1240x1240px · infant wide-field fundus photograph · Phoenix ICON, 100° FOV.
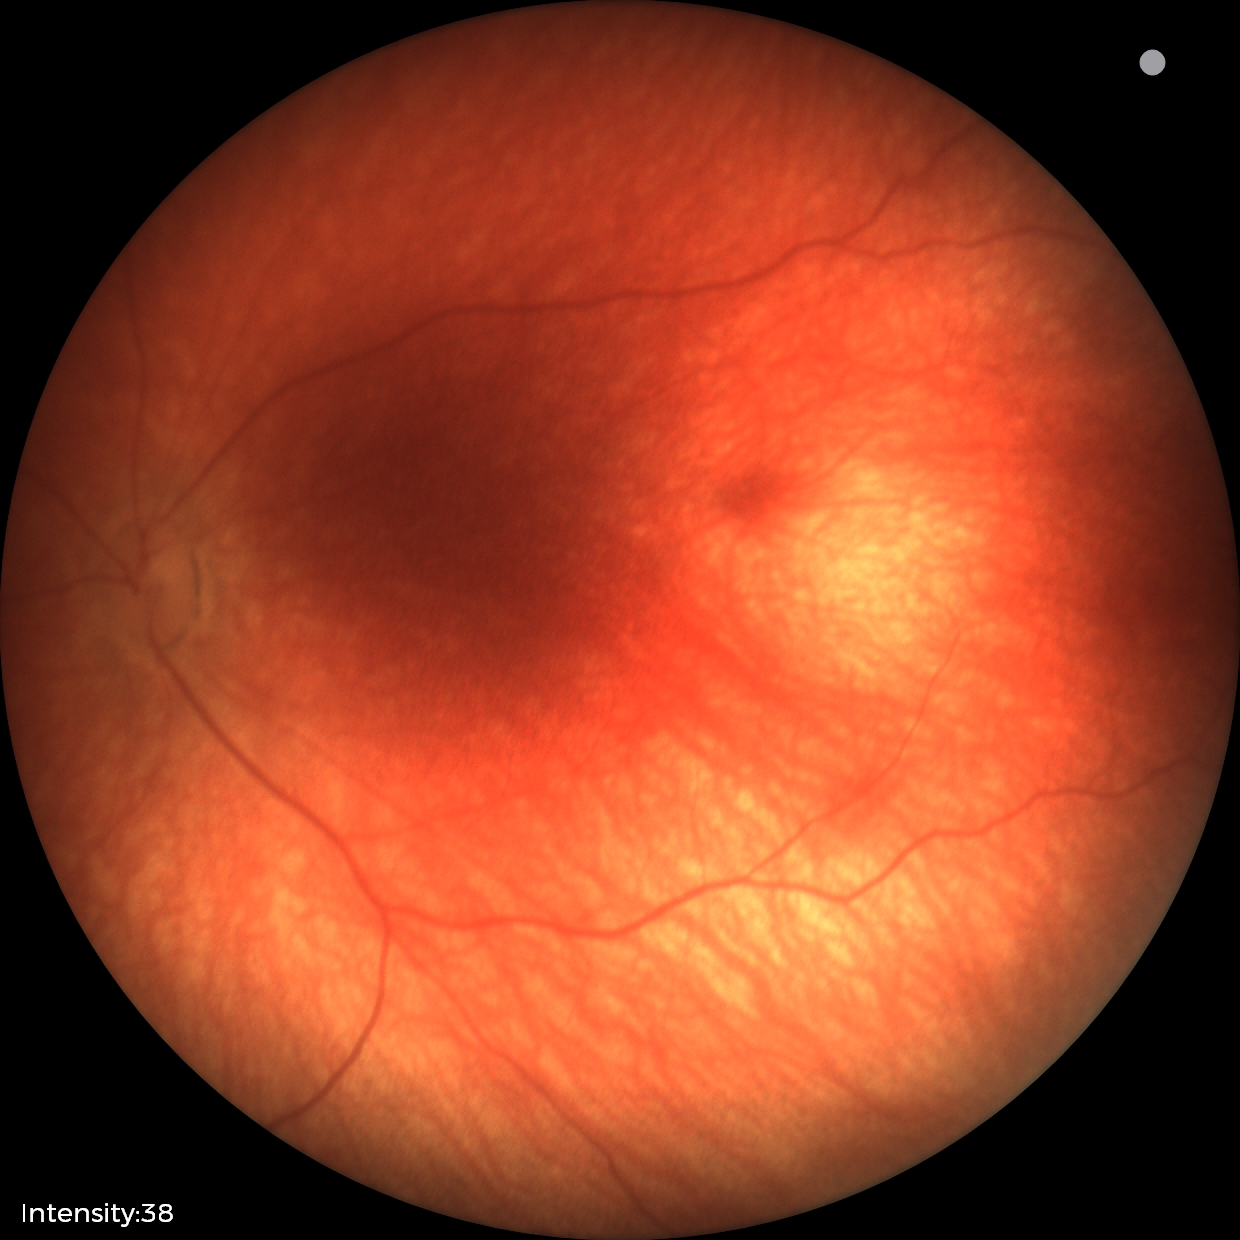
Screening: retinal hemorrhages.